DR severity per modified Davis staging:
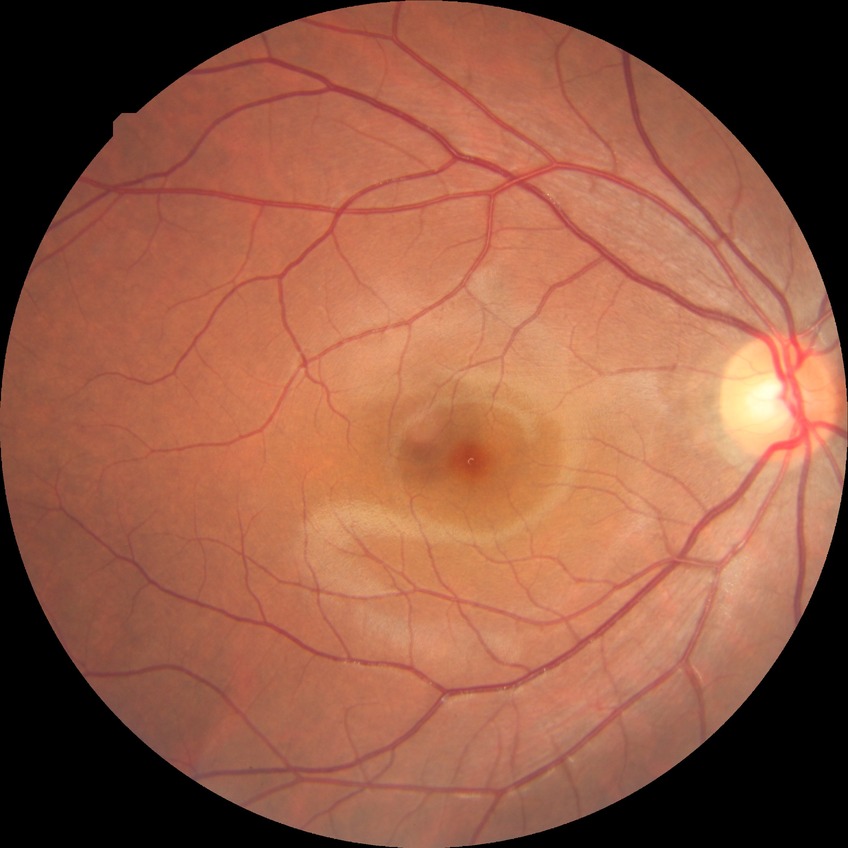

Davis stage: NDR, DR impression: no signs of DR.